1470 by 1137 pixels. 45° field of view. Color fundus image
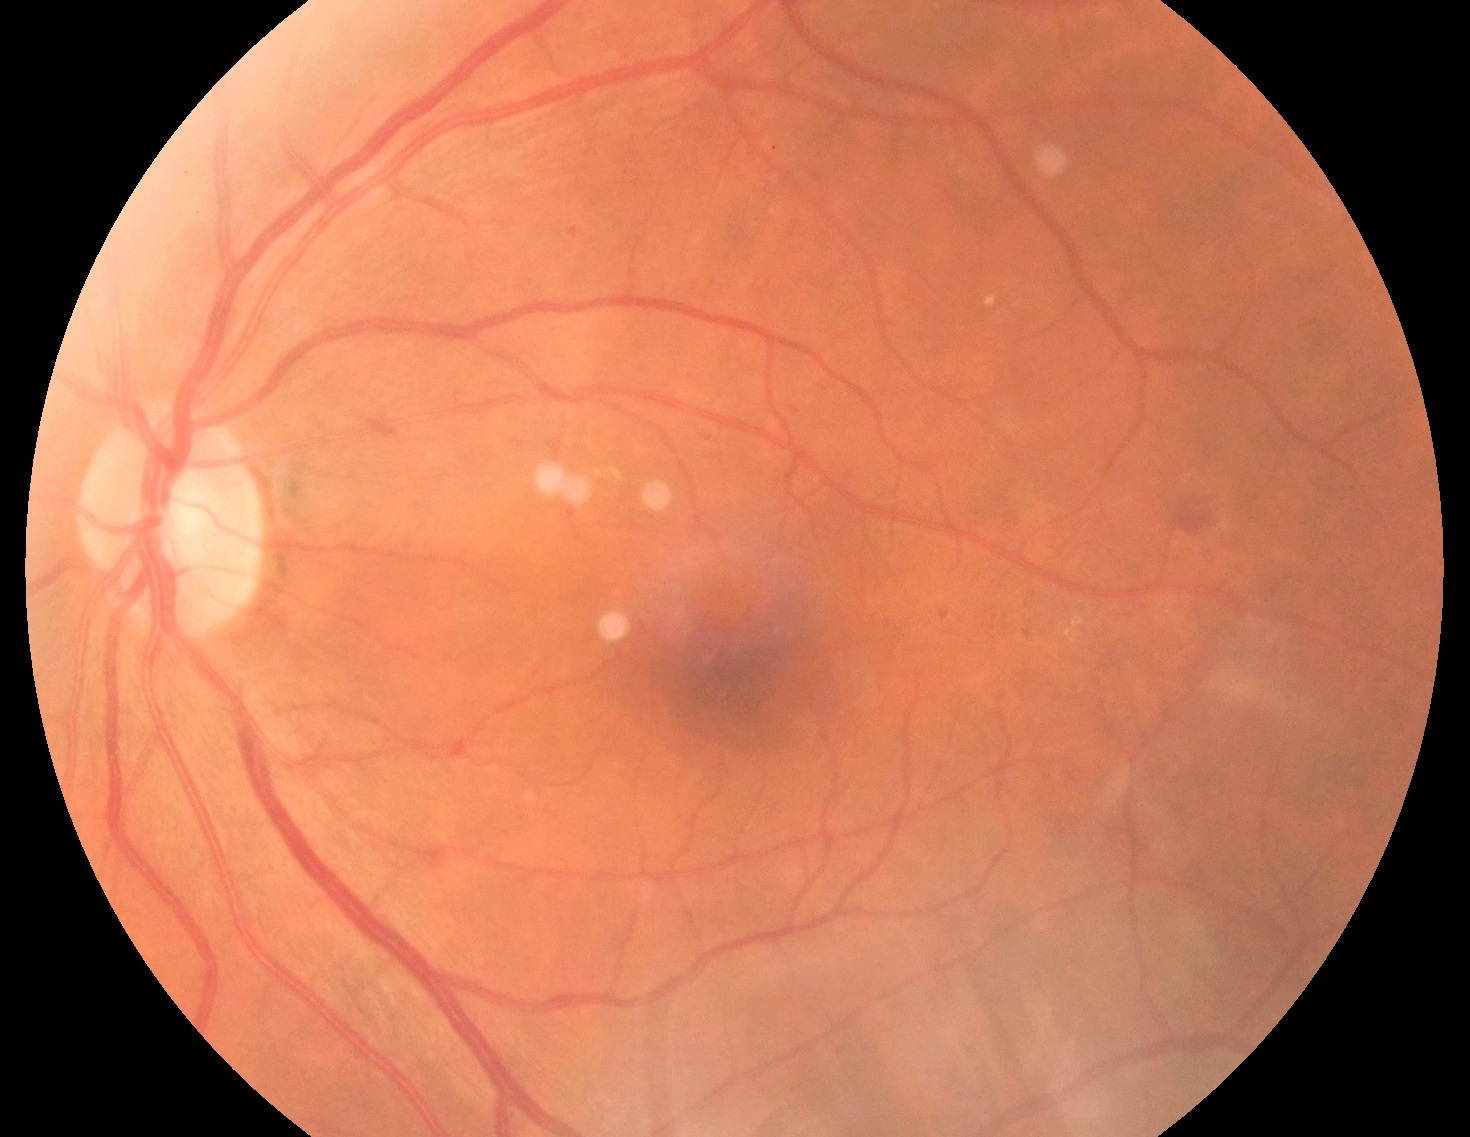

DR grade: 2 (moderate NPDR).